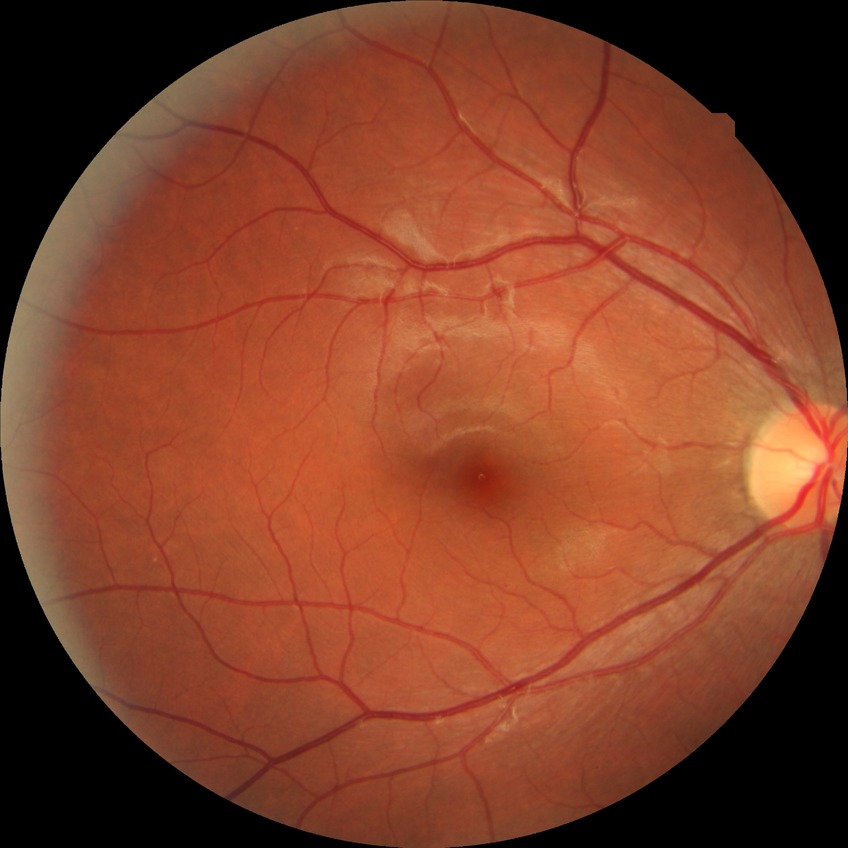 Modified Davis grade: NDR.
No DR findings.